CFP:
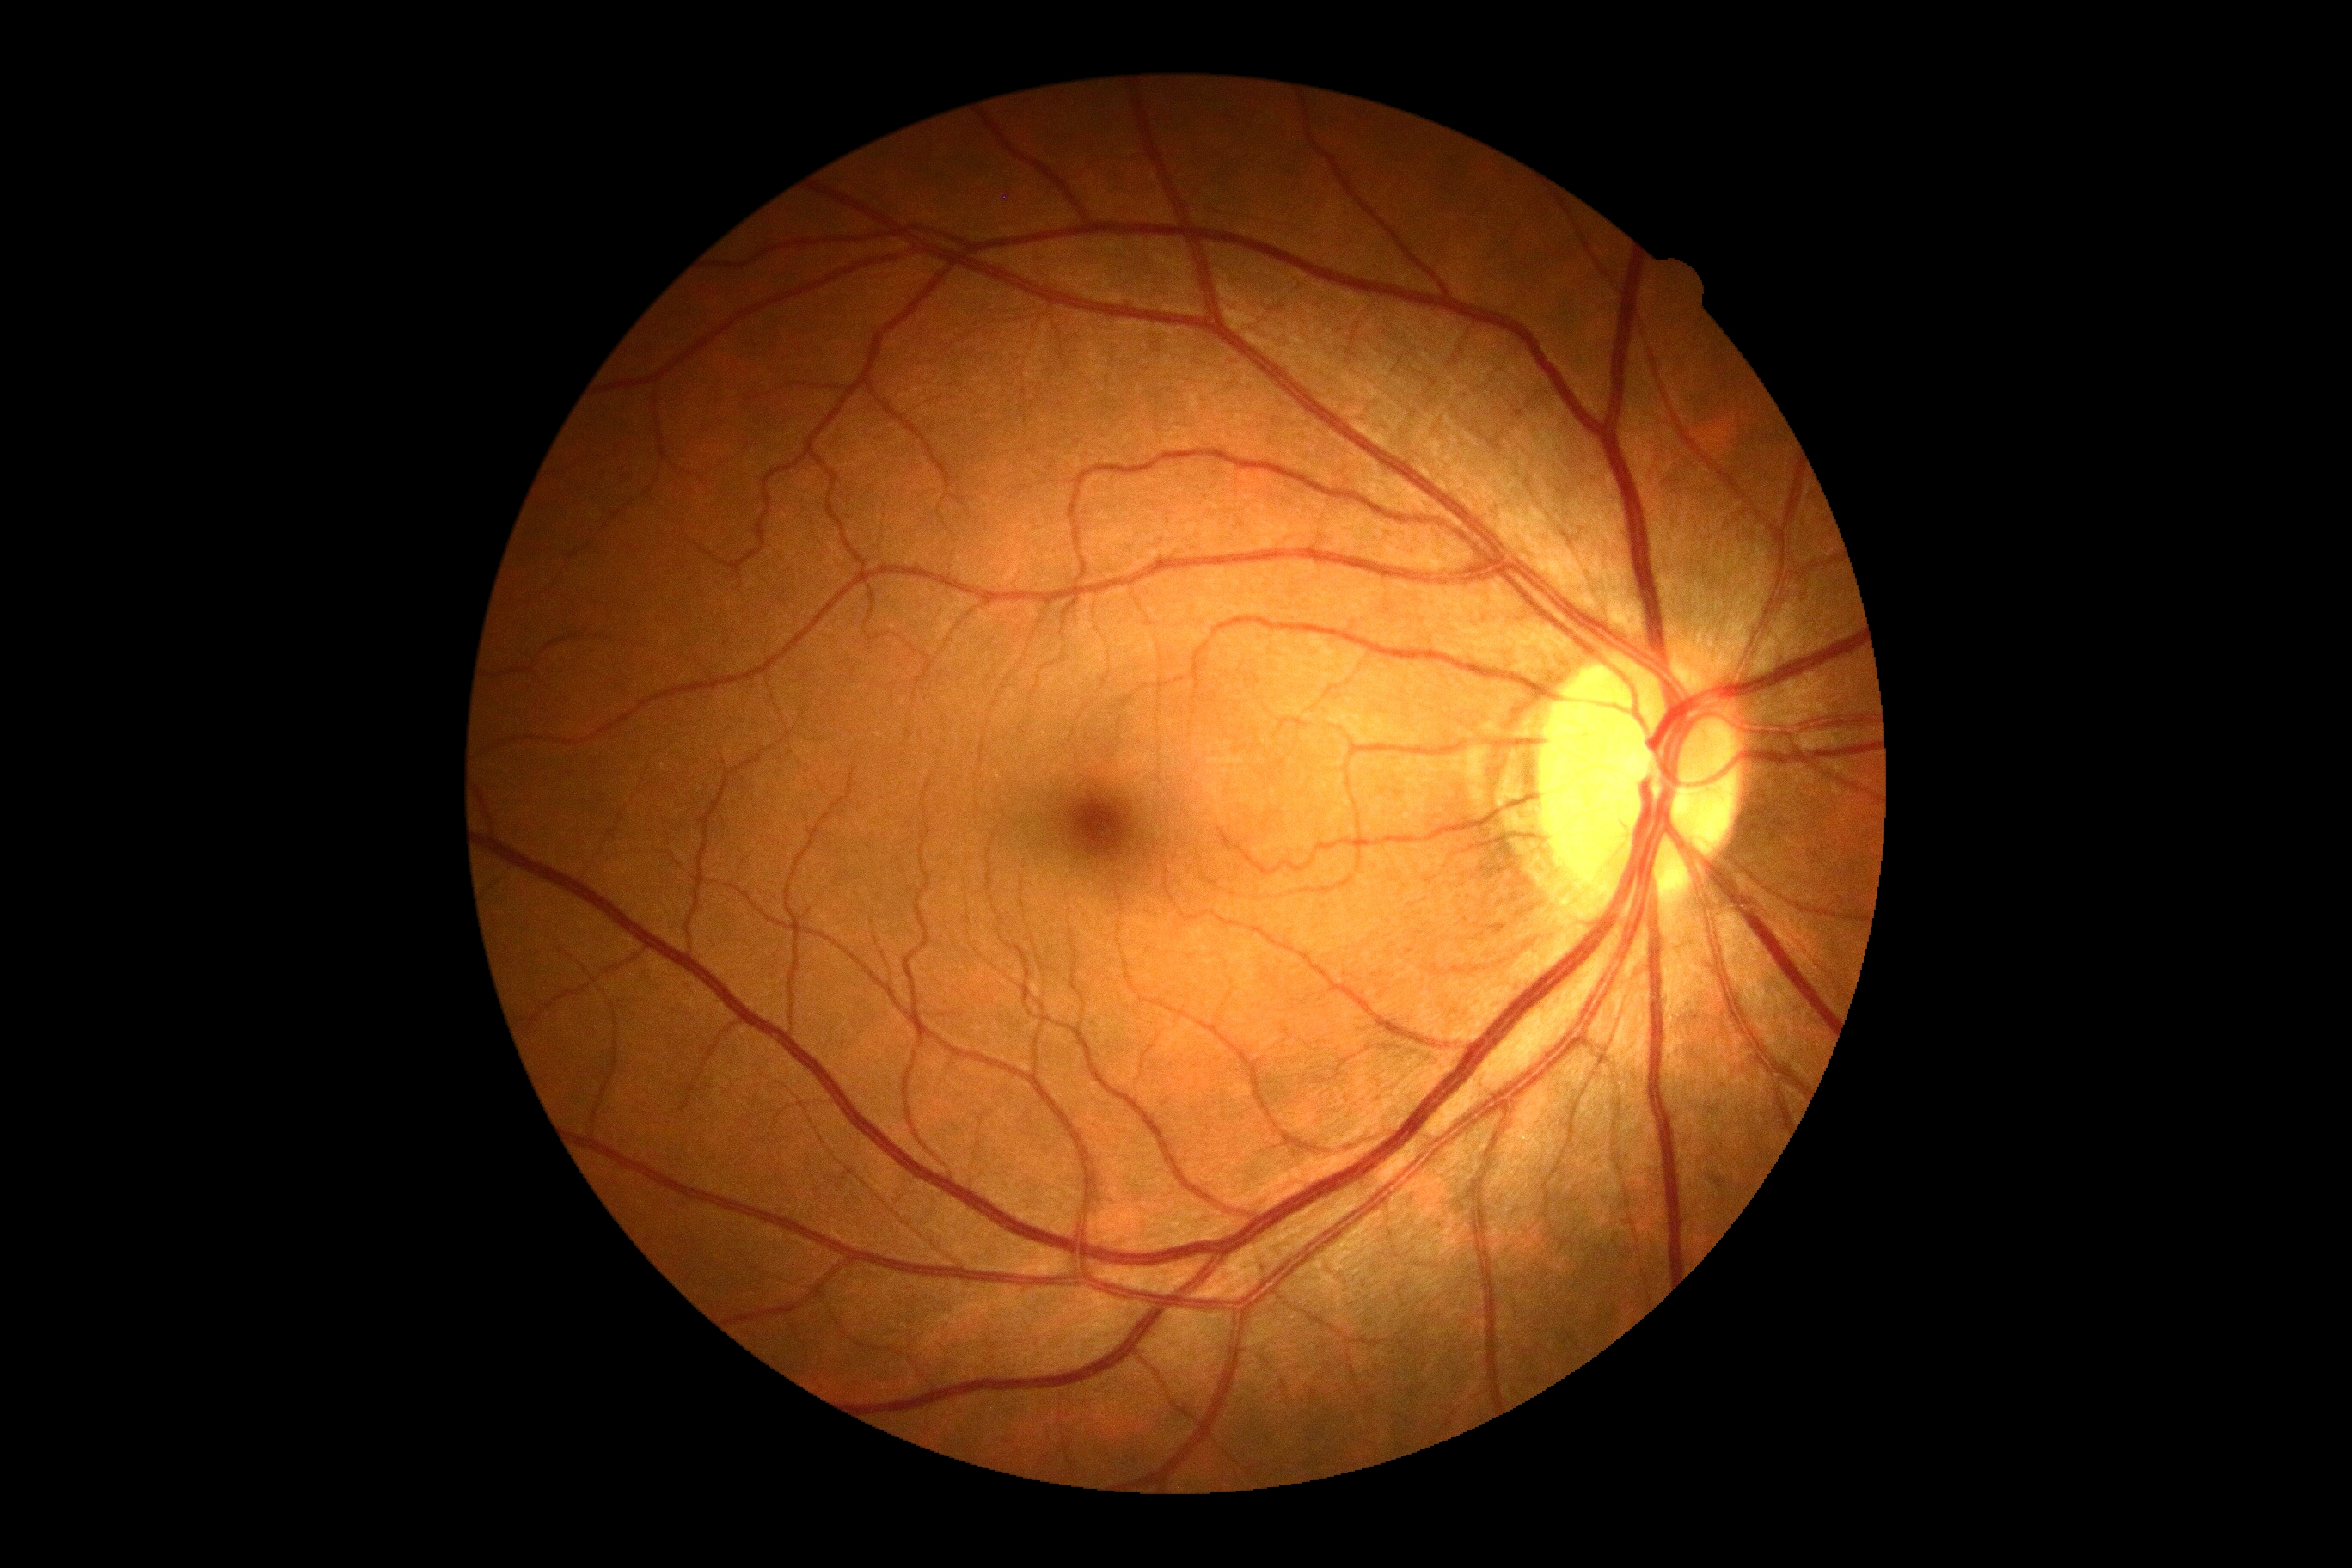

DR grade: 0 (no apparent retinopathy).